1534 by 1534 pixels; CFP:
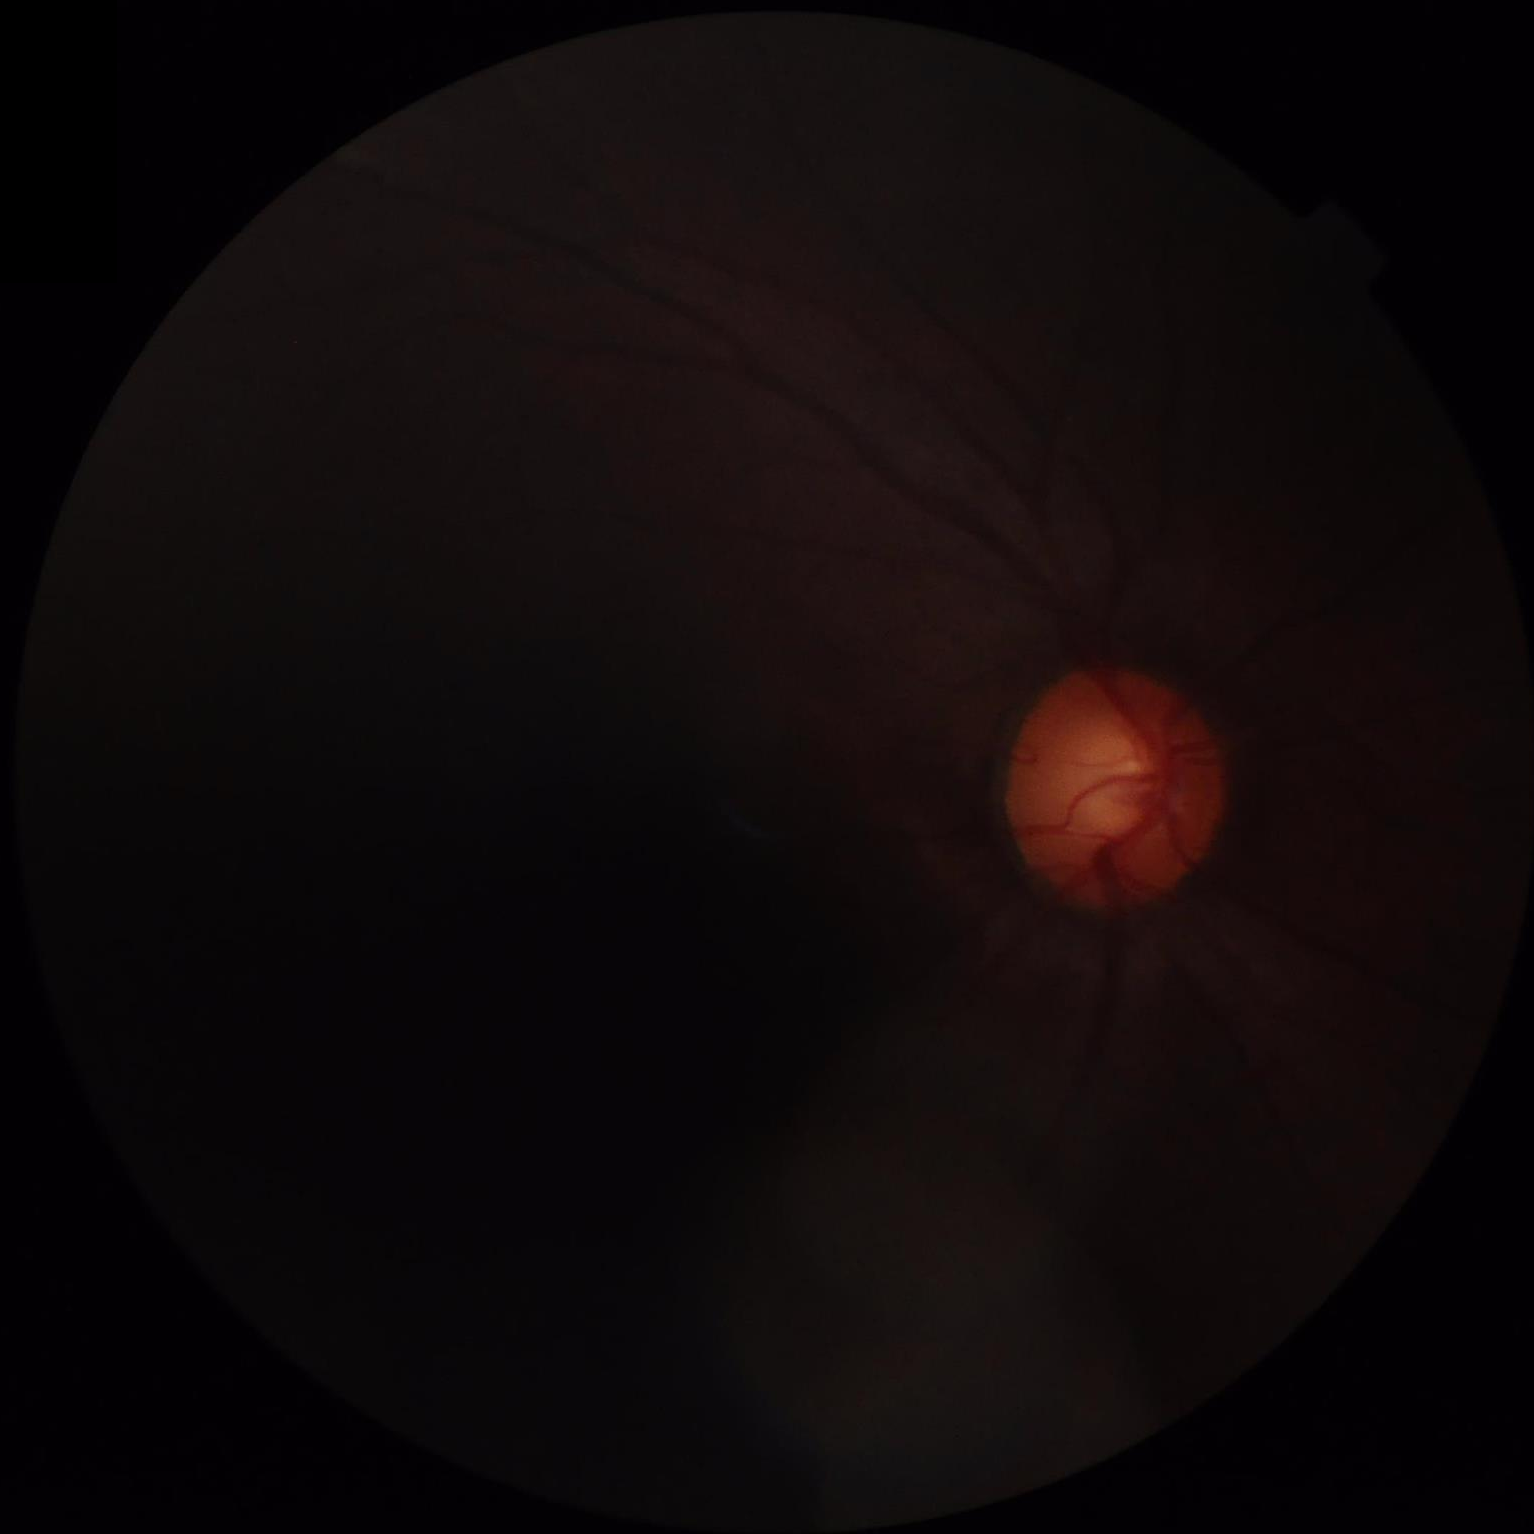
{
  "illumination": "uneven illumination or color cast",
  "contrast": "poor dynamic range",
  "clarity": "reduced sharpness with visible blur",
  "overall_quality": "inadequate for clinical interpretation"
}